Color fundus image — 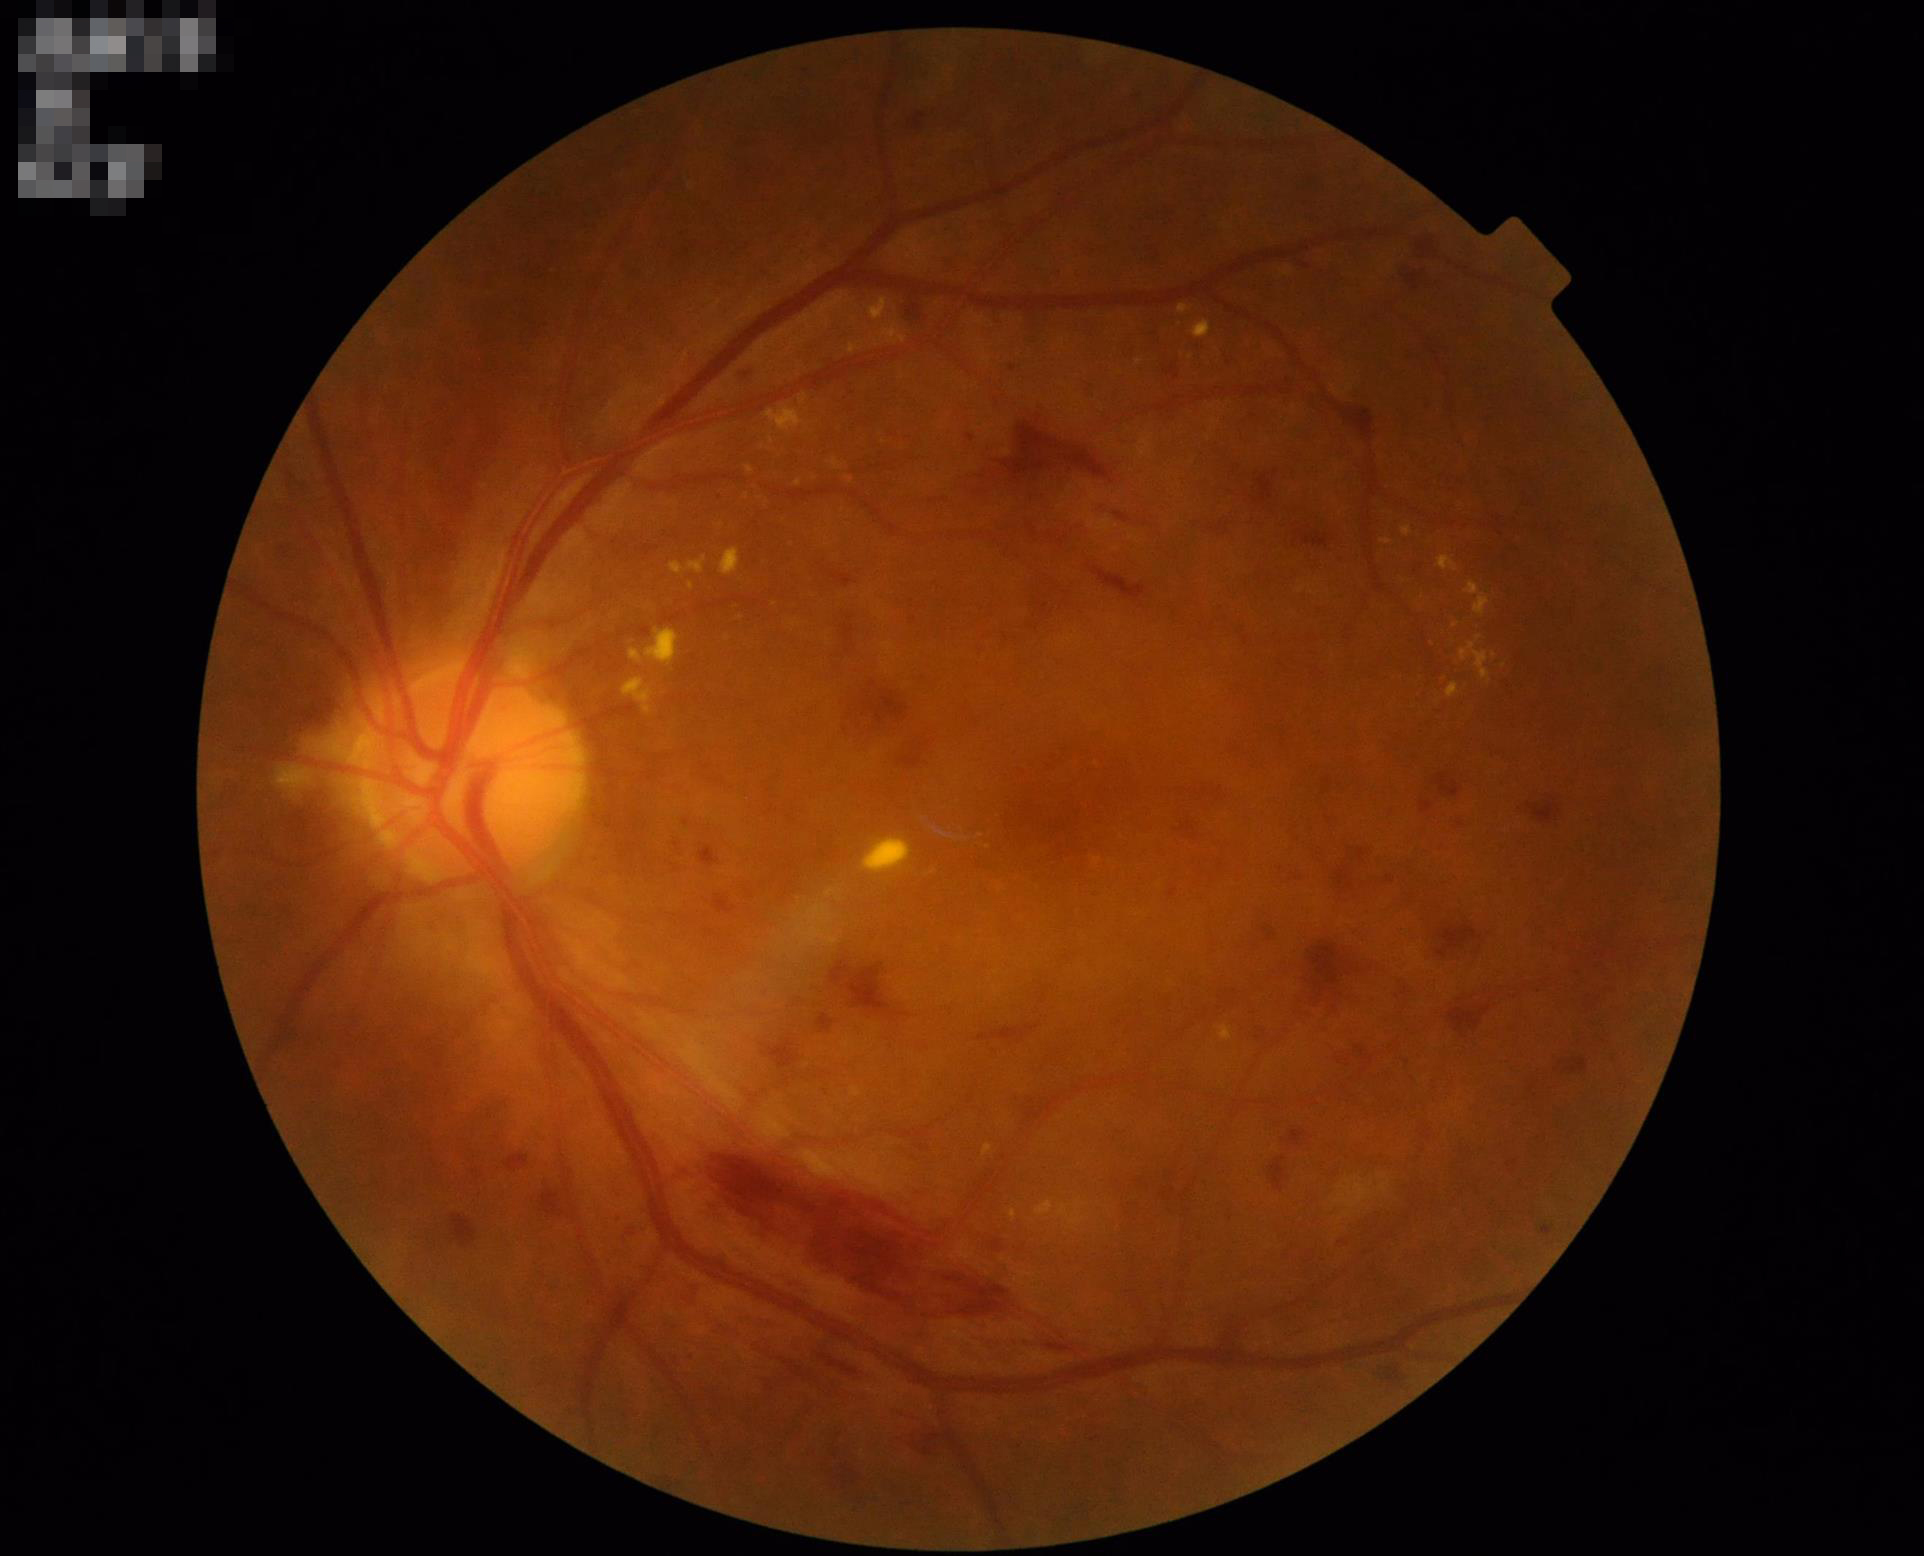
Image quality is adequate for diagnostic use. Adequate contrast for distinguishing structures.